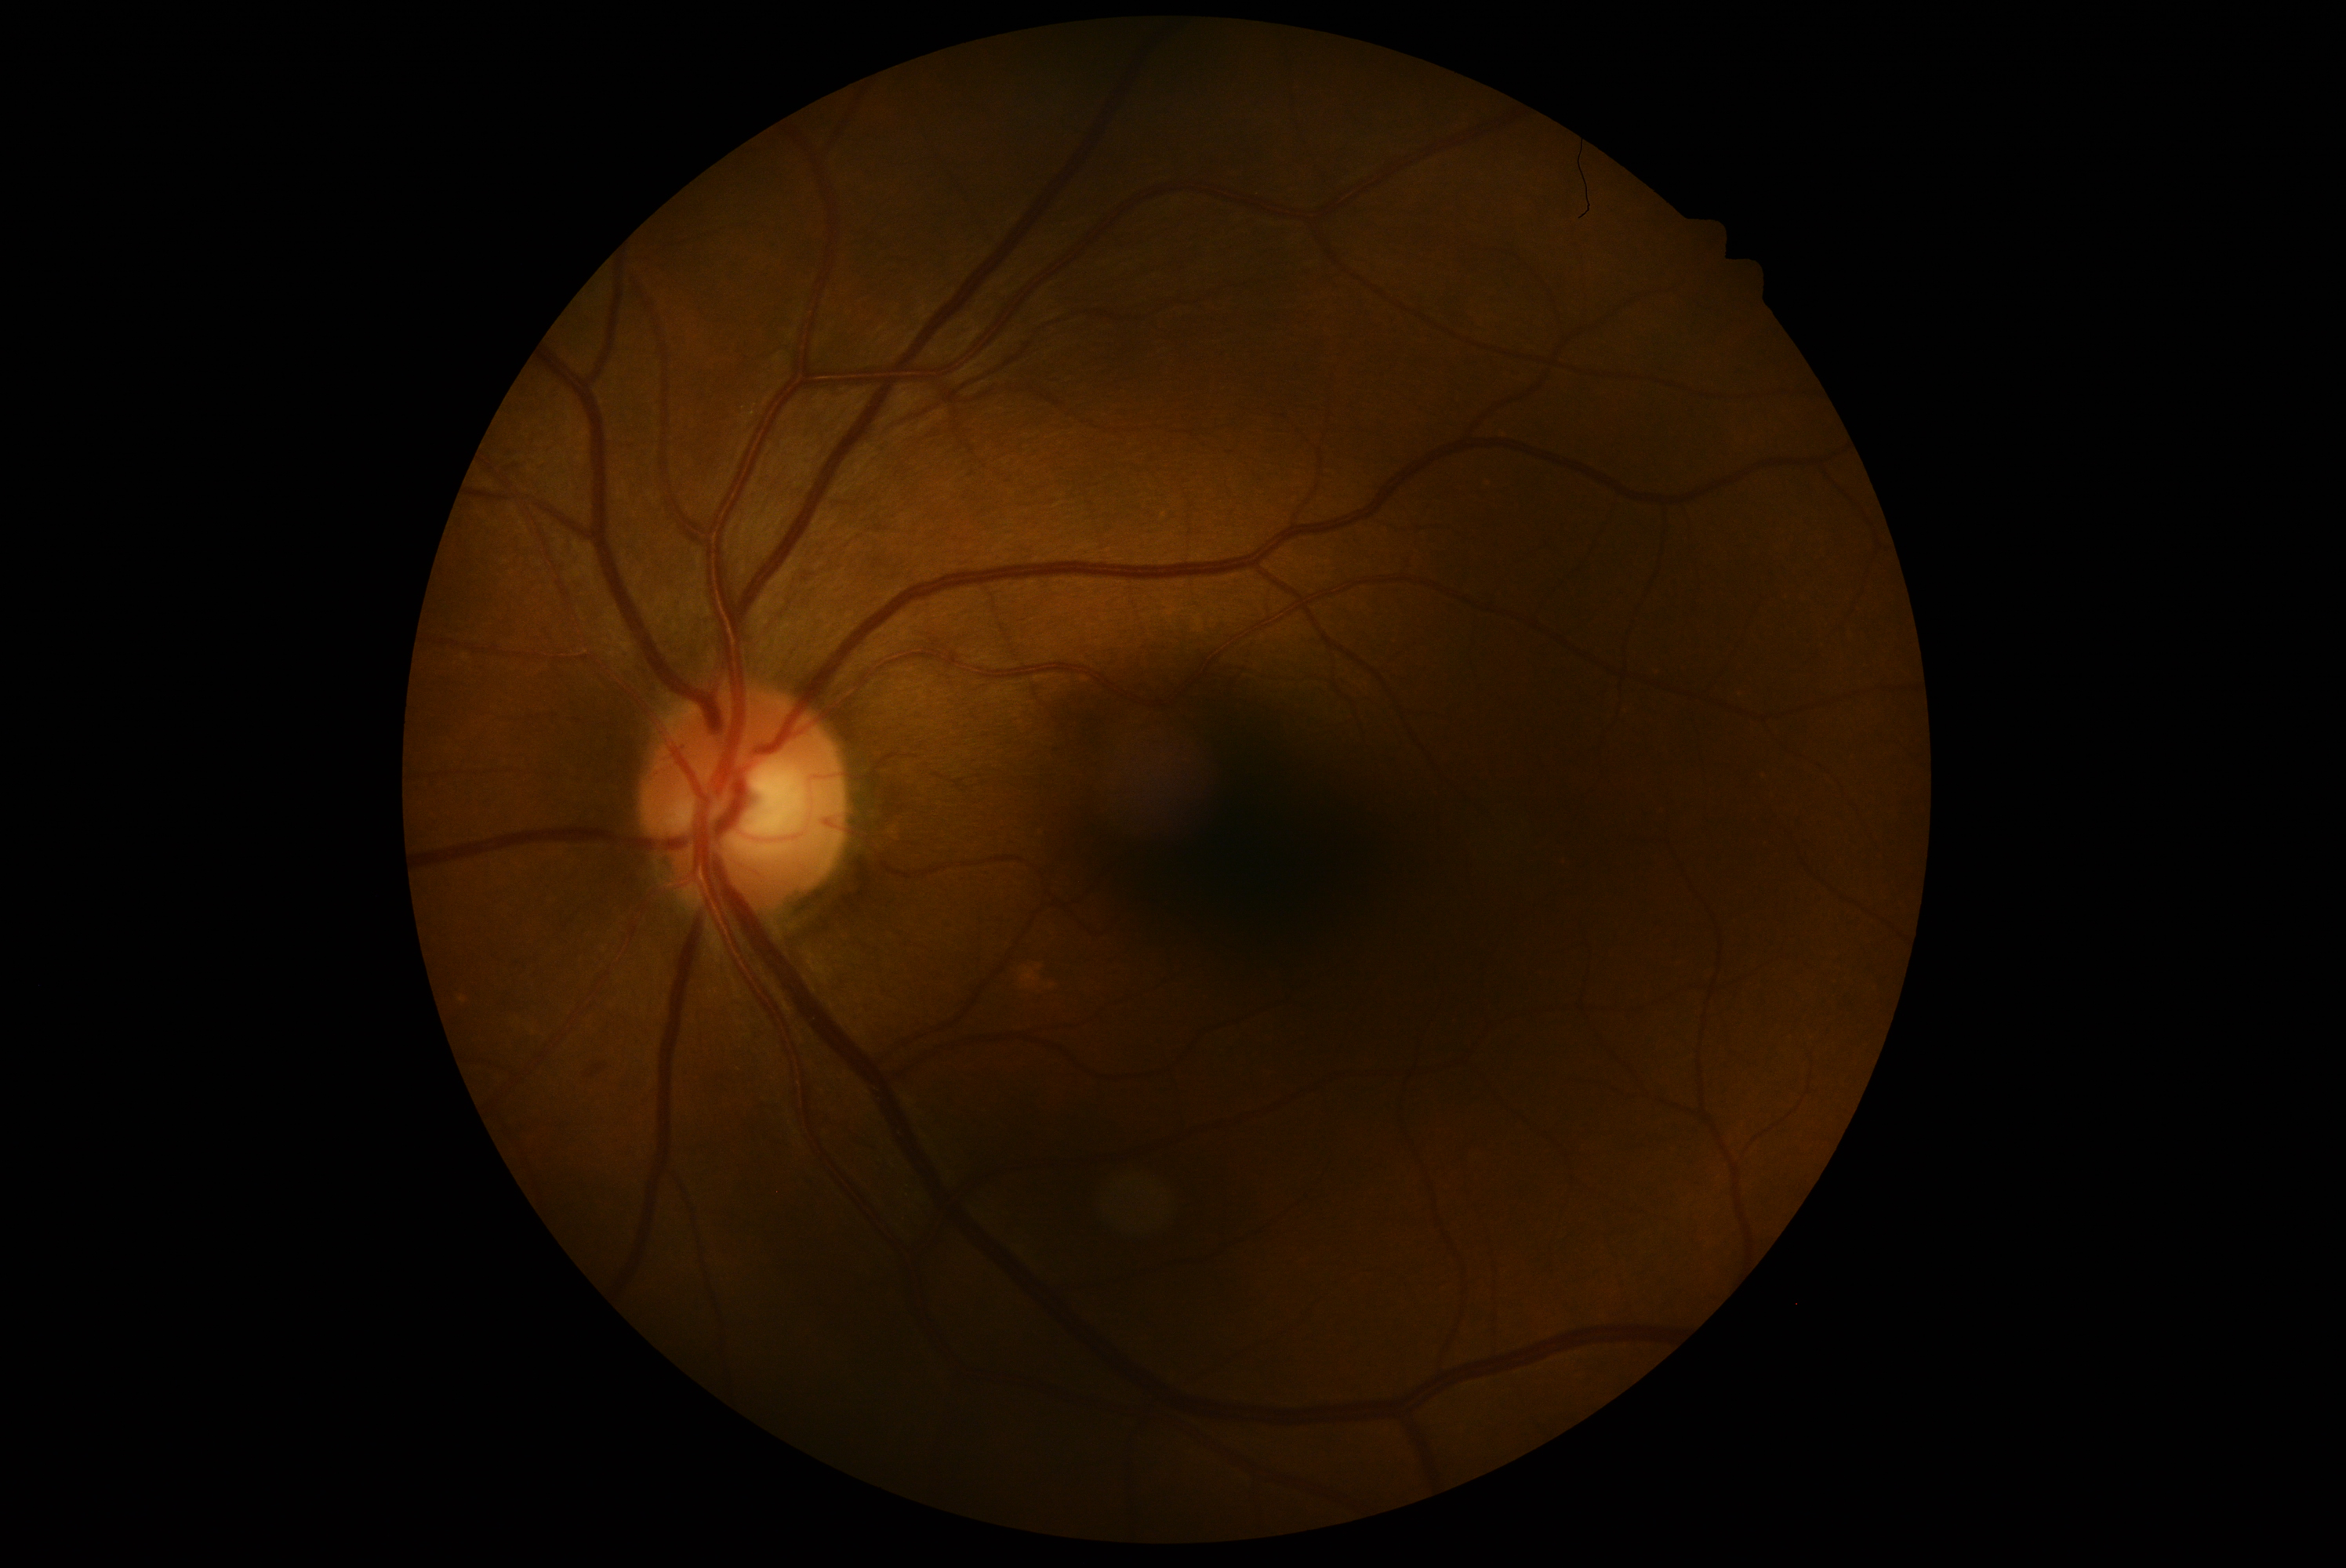
Diabetic retinopathy (DR): 2.